240 by 240 pixels.
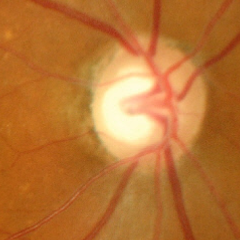

Glaucoma status: advanced glaucoma.